Image size 2184x1690:
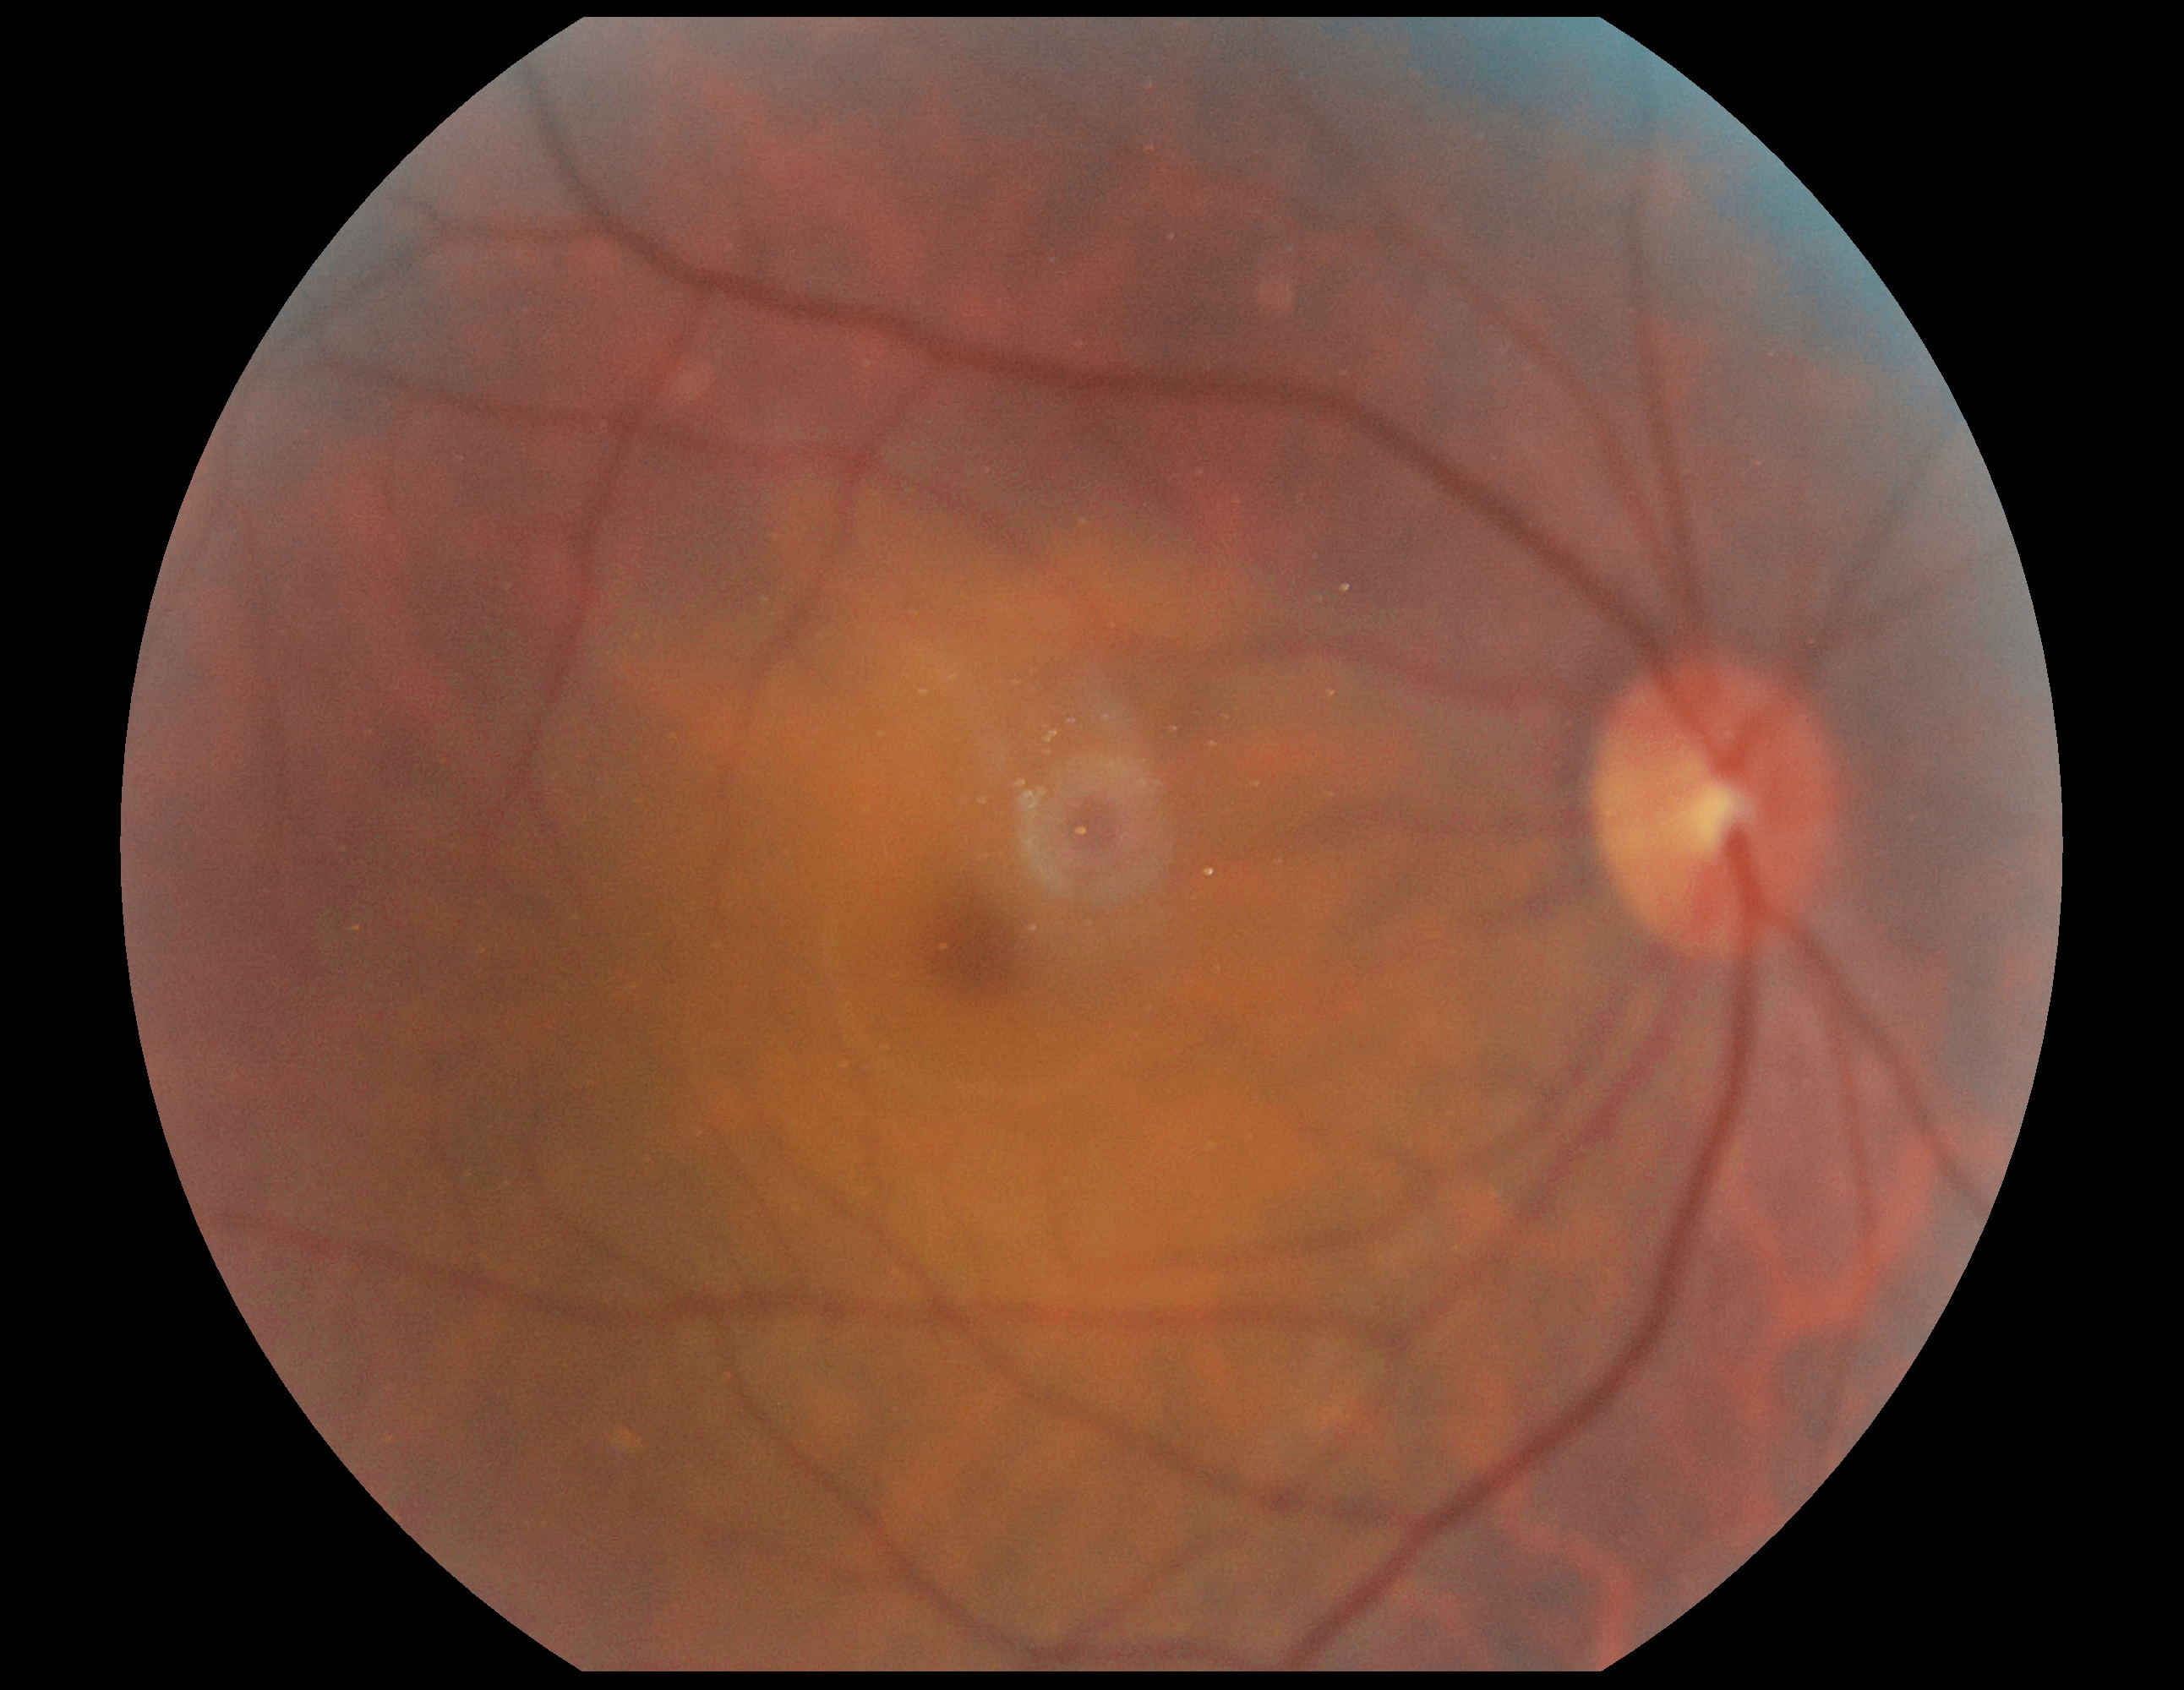 DR stage: 0.